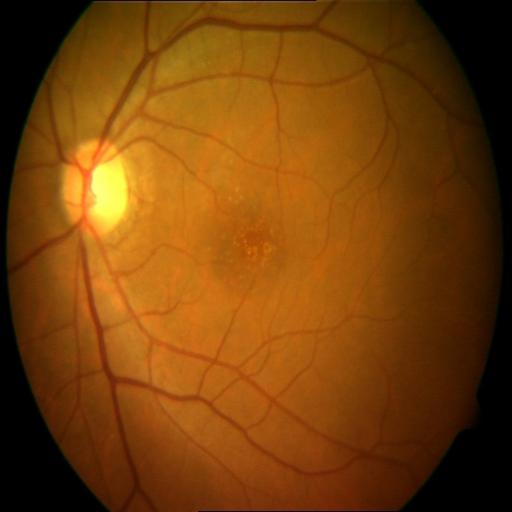
Two abnormalities. Fundus appearance consistent with age-related macular degeneration (ARMD) & optic disc cupping (ODC).